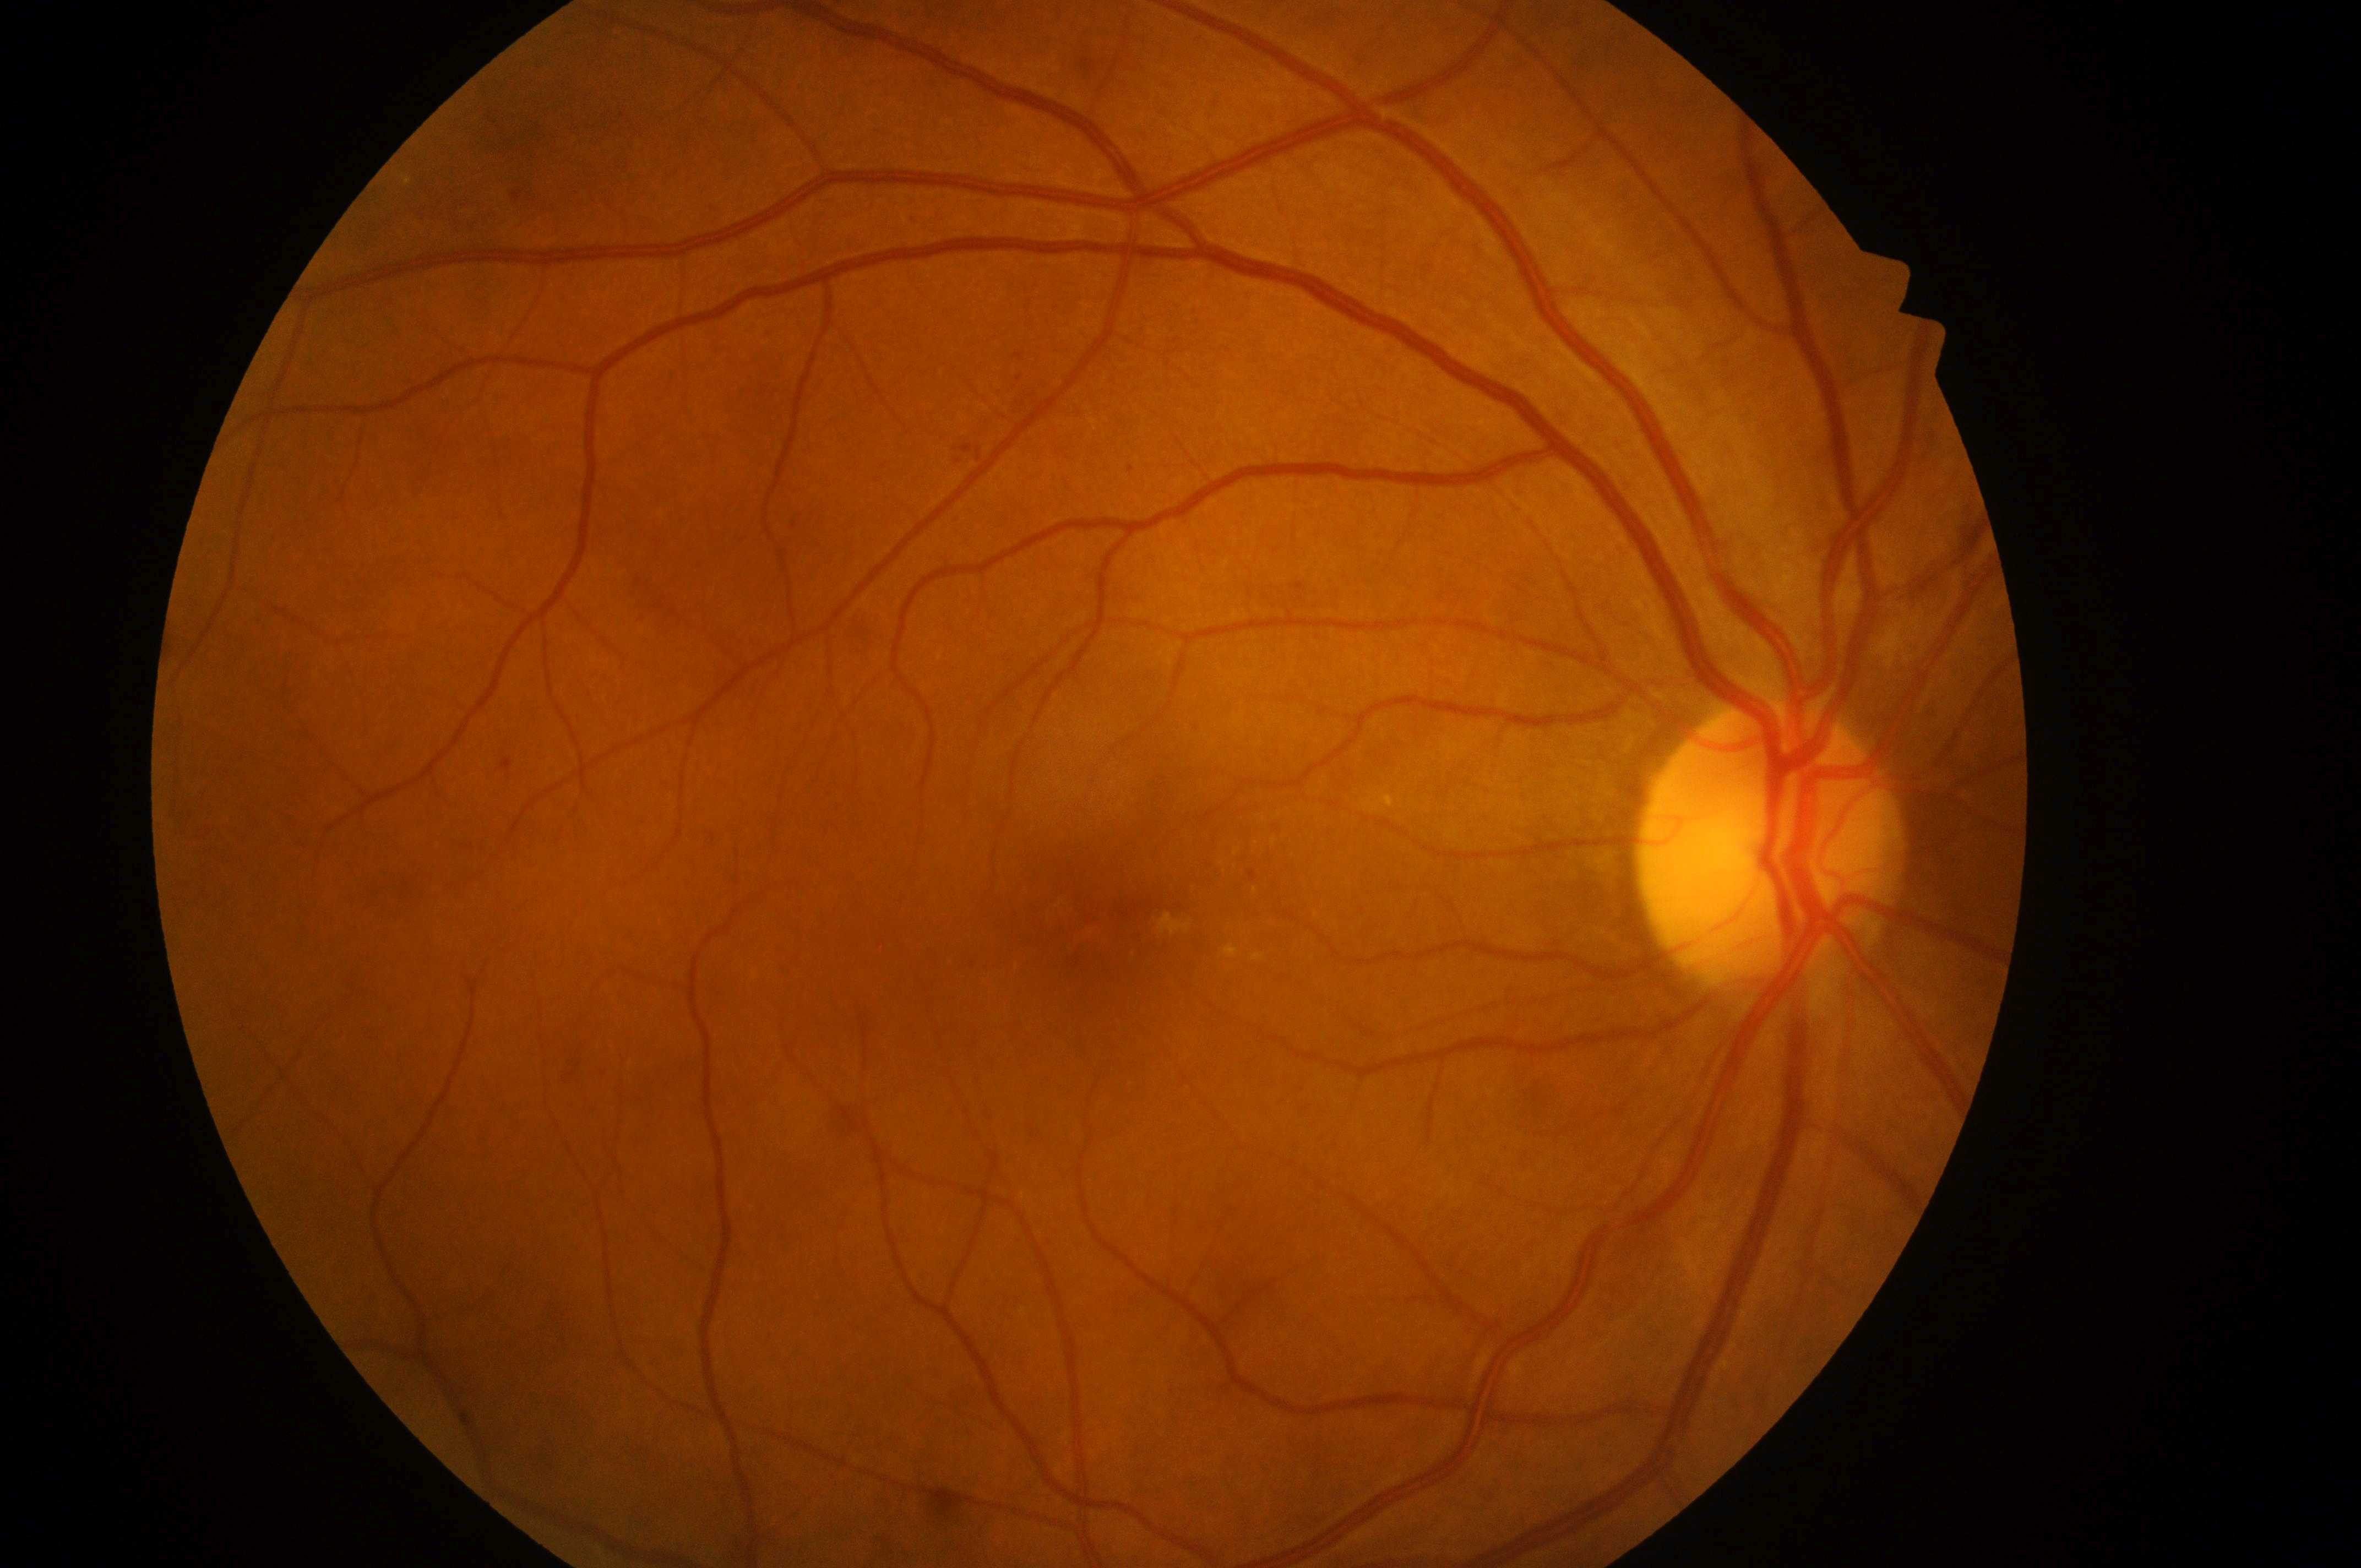
Imaged eye: right eye.
DR: grade 2 (moderate NPDR) — more than just microaneurysms but less than severe NPDR.
DME grade: high risk (2) — hard exudates within one disc diameter of the macula center.
The optic disc is at 1764px, 859px.
The retinopathy is classified as non-proliferative diabetic retinopathy.
The fovea center is at 1109px, 925px.